Wide-field fundus photograph of an infant. 640x480px. Clarity RetCam 3, 130° FOV:
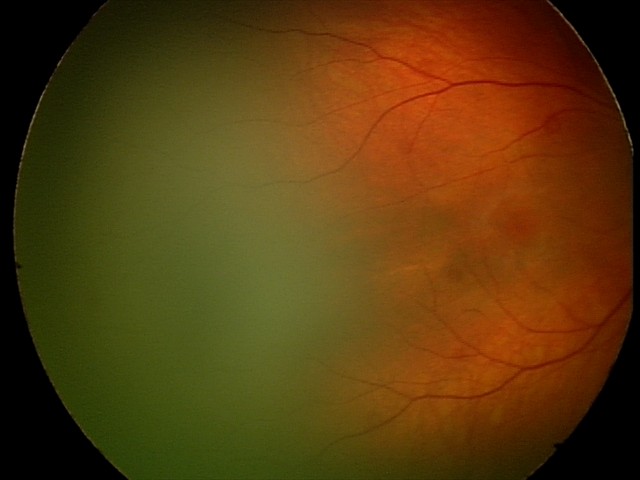
Q: What was the screening finding?
A: retinal hemorrhages